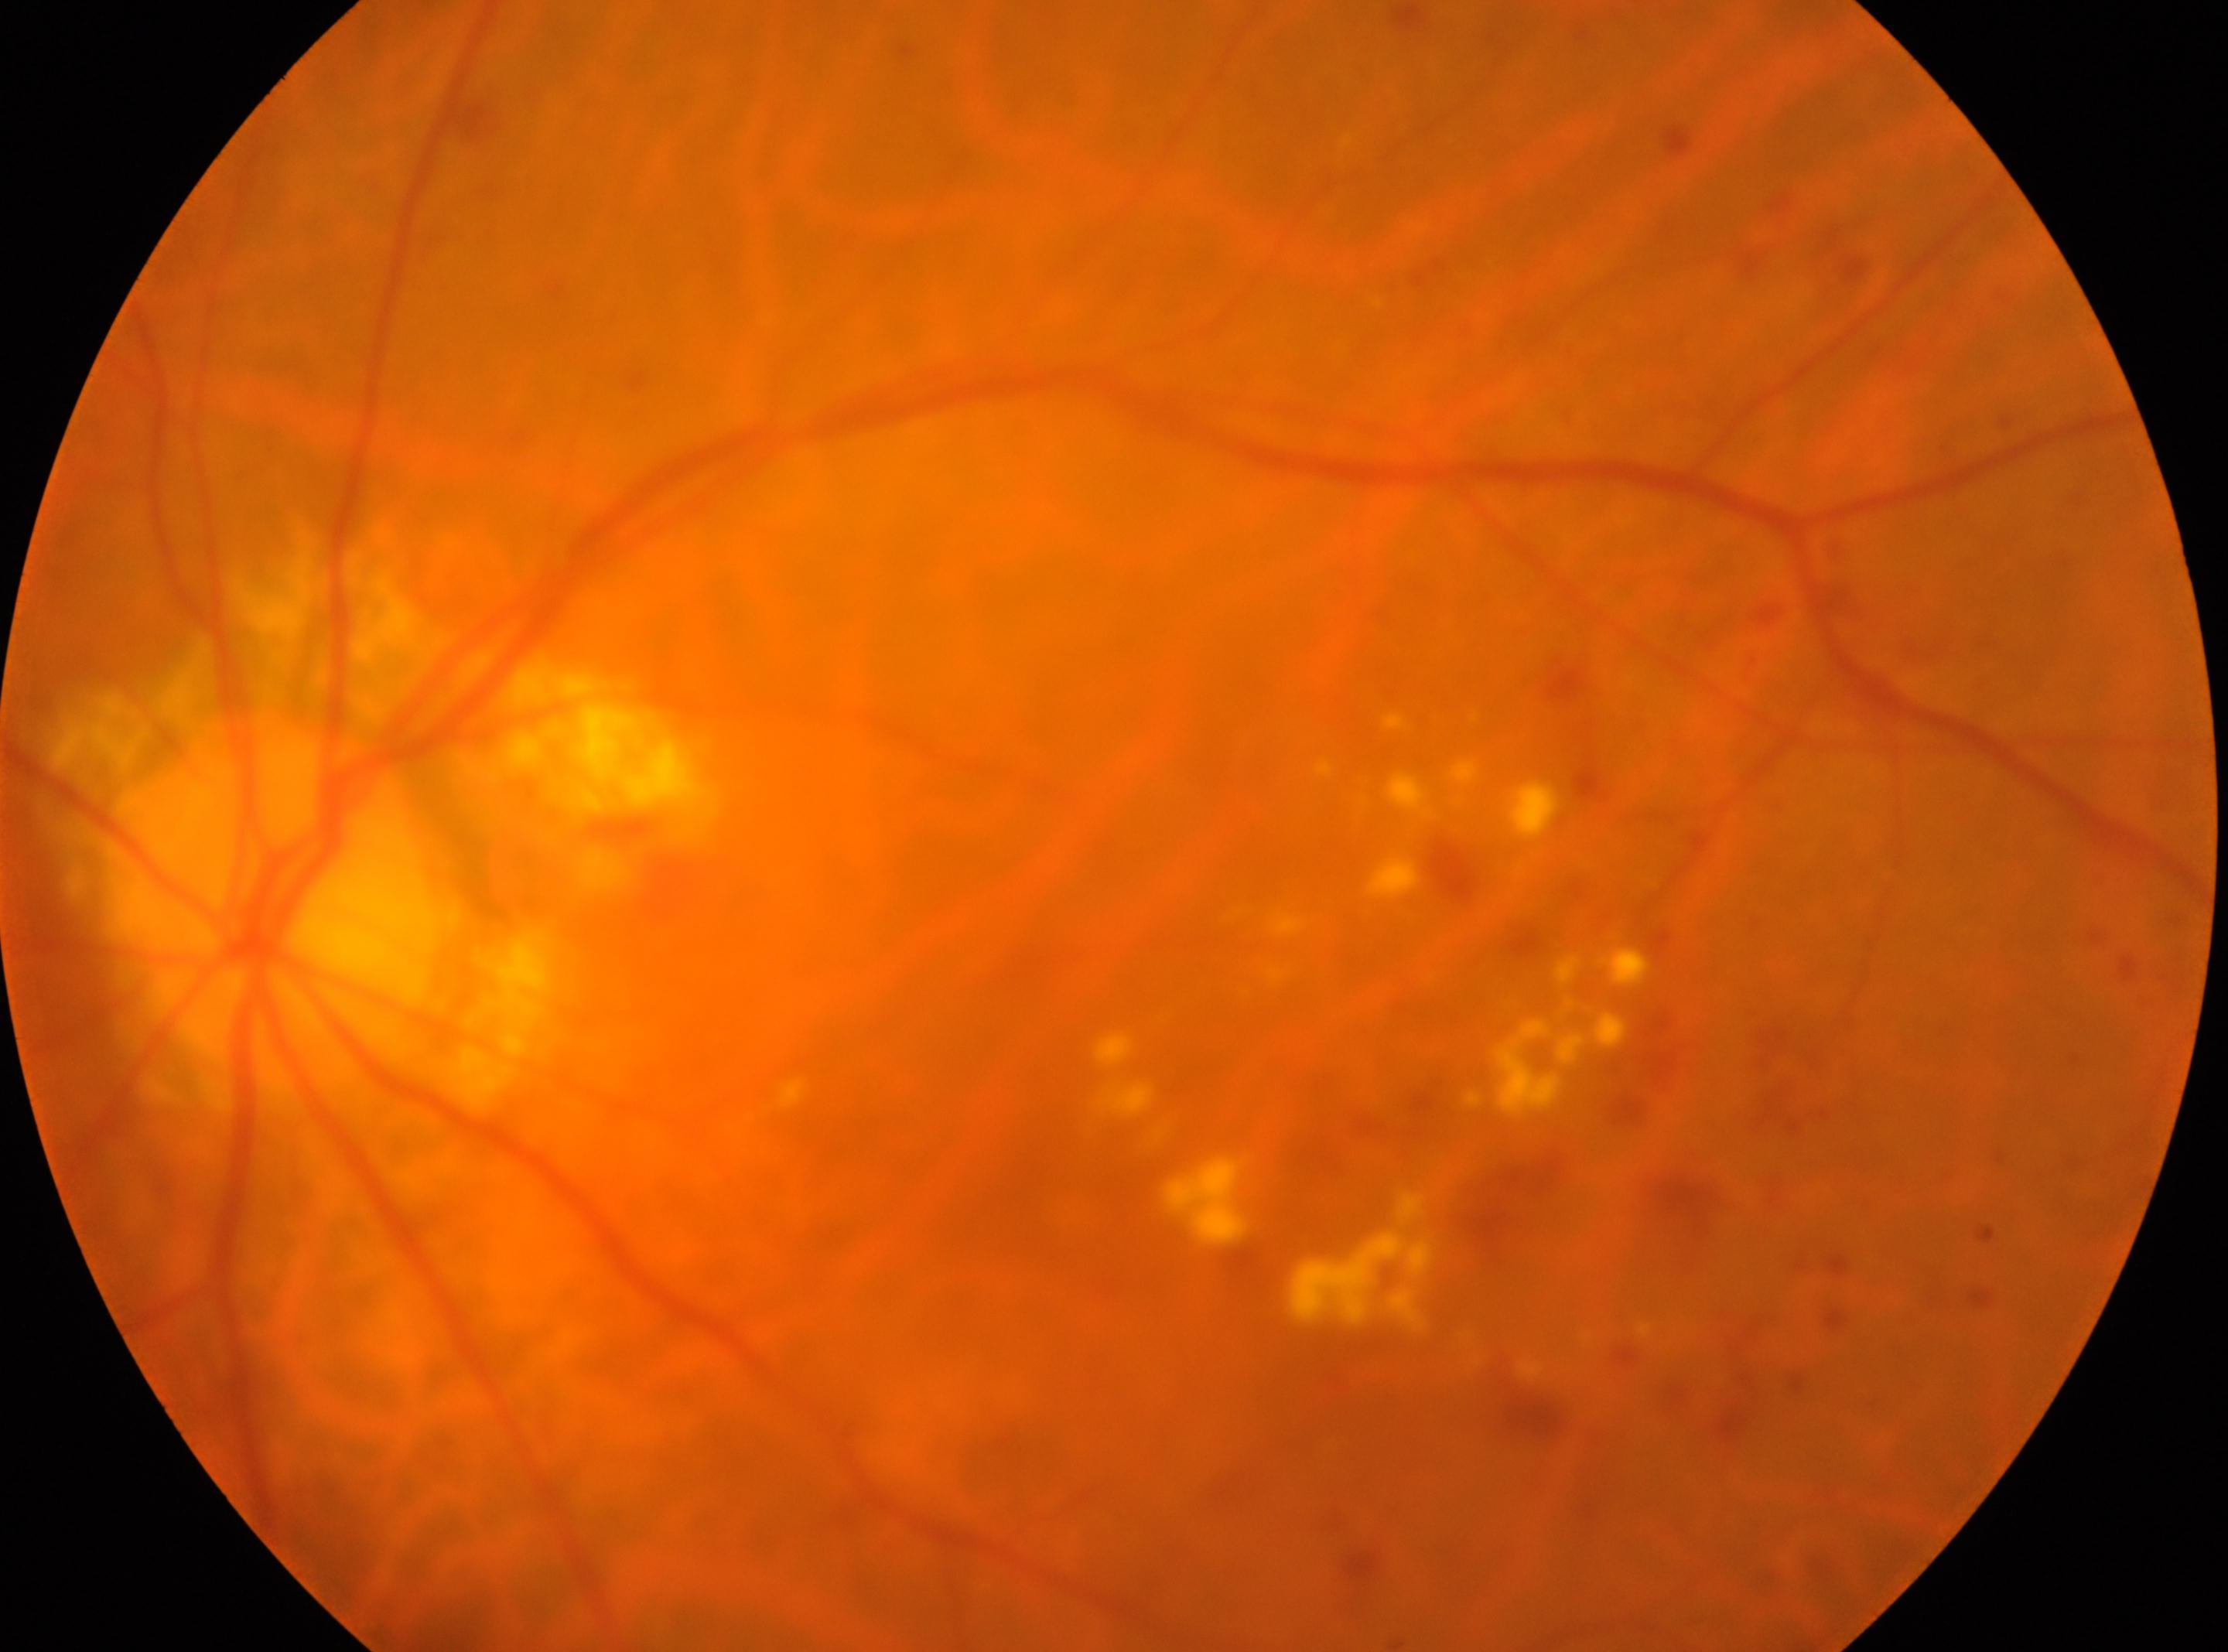 {
  "optic_disc": "273px, 903px",
  "eye": "left eye",
  "dr_grade": "2",
  "fovea": "1072px, 1154px"
}